Fundus photo; modified Davis grading; 45° FOV; 848x848; acquired with a NIDEK AFC-230
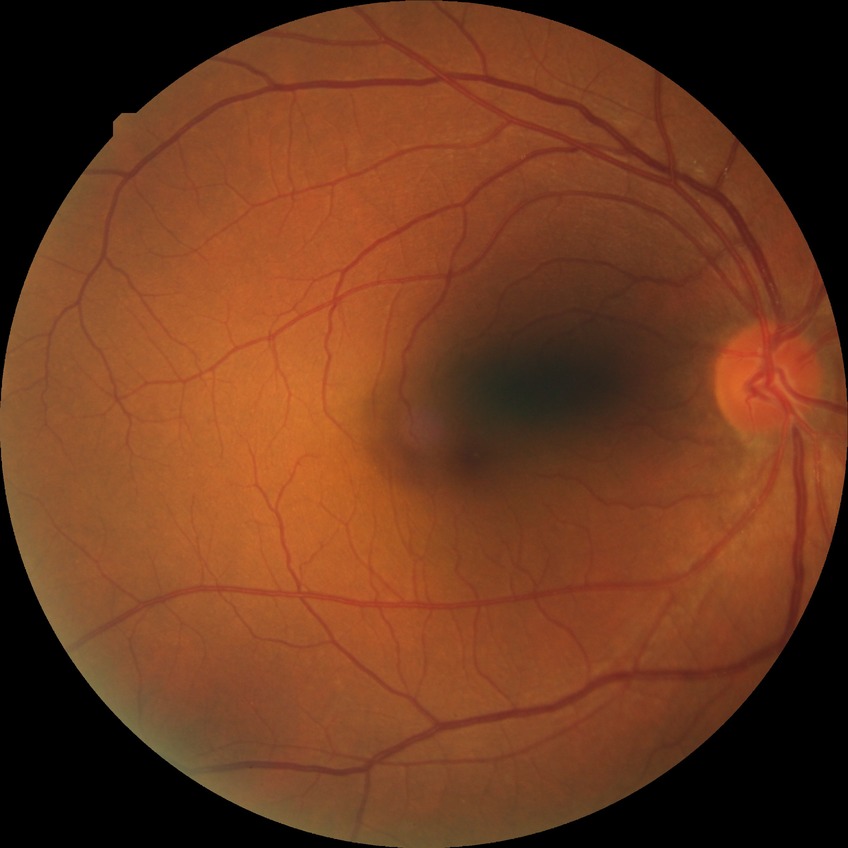

Diabetic retinopathy (DR): NDR (no diabetic retinopathy).